RetCam wide-field infant fundus image · camera: Natus RetCam Envision (130° FOV) — 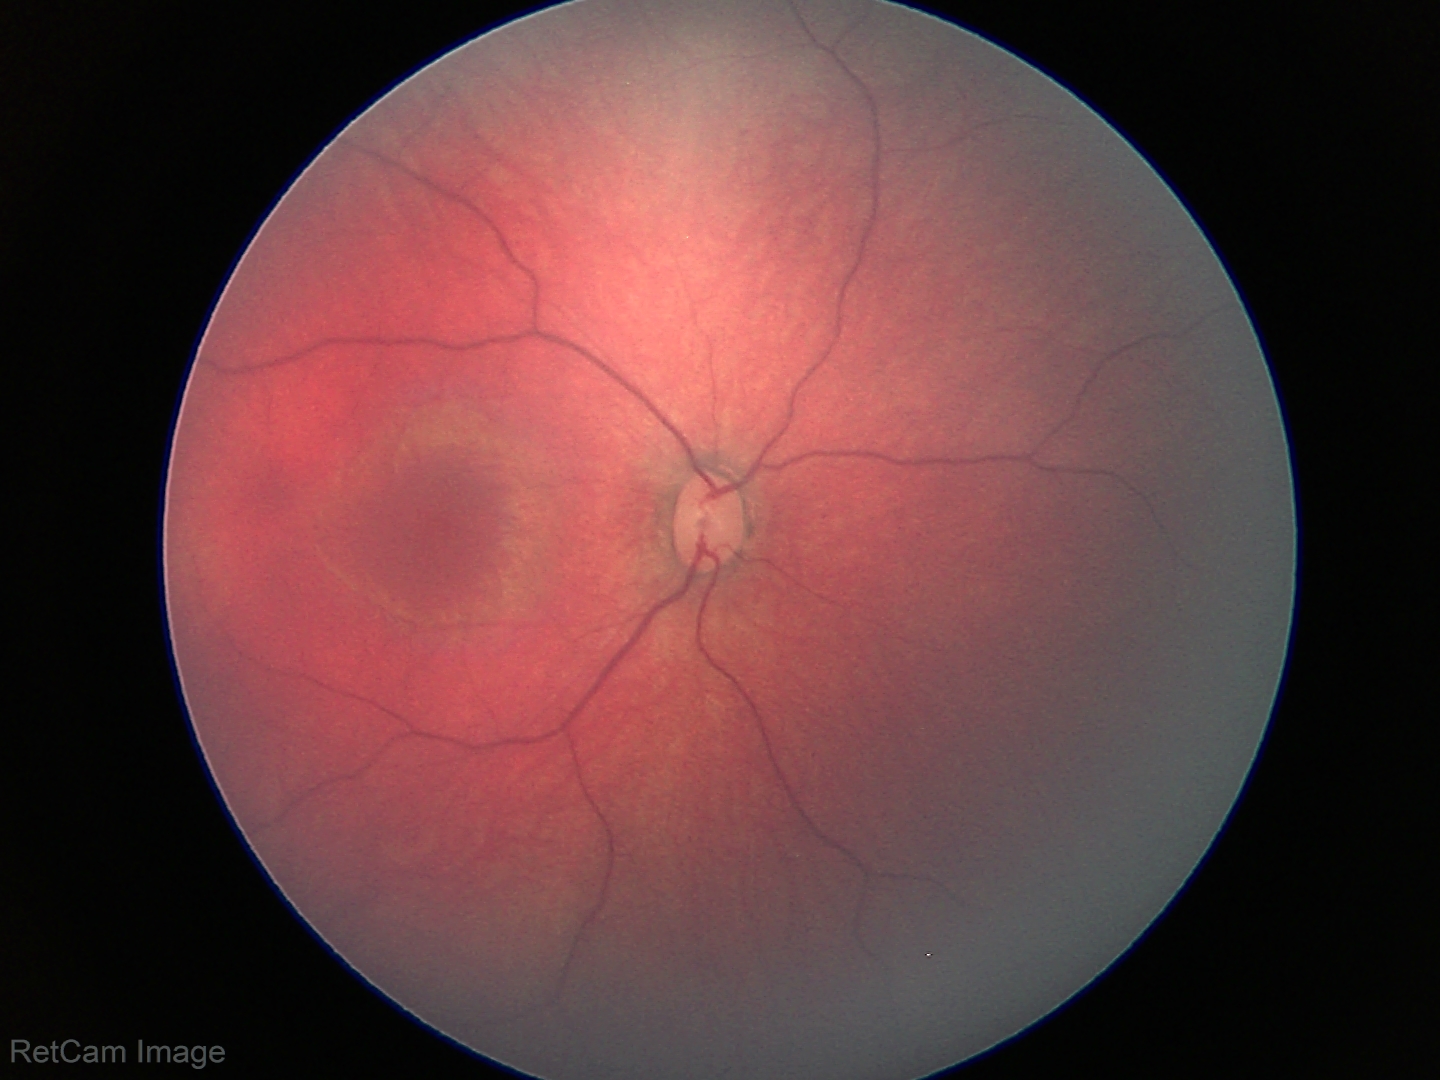

Screening examination with no abnormal retinal findings.